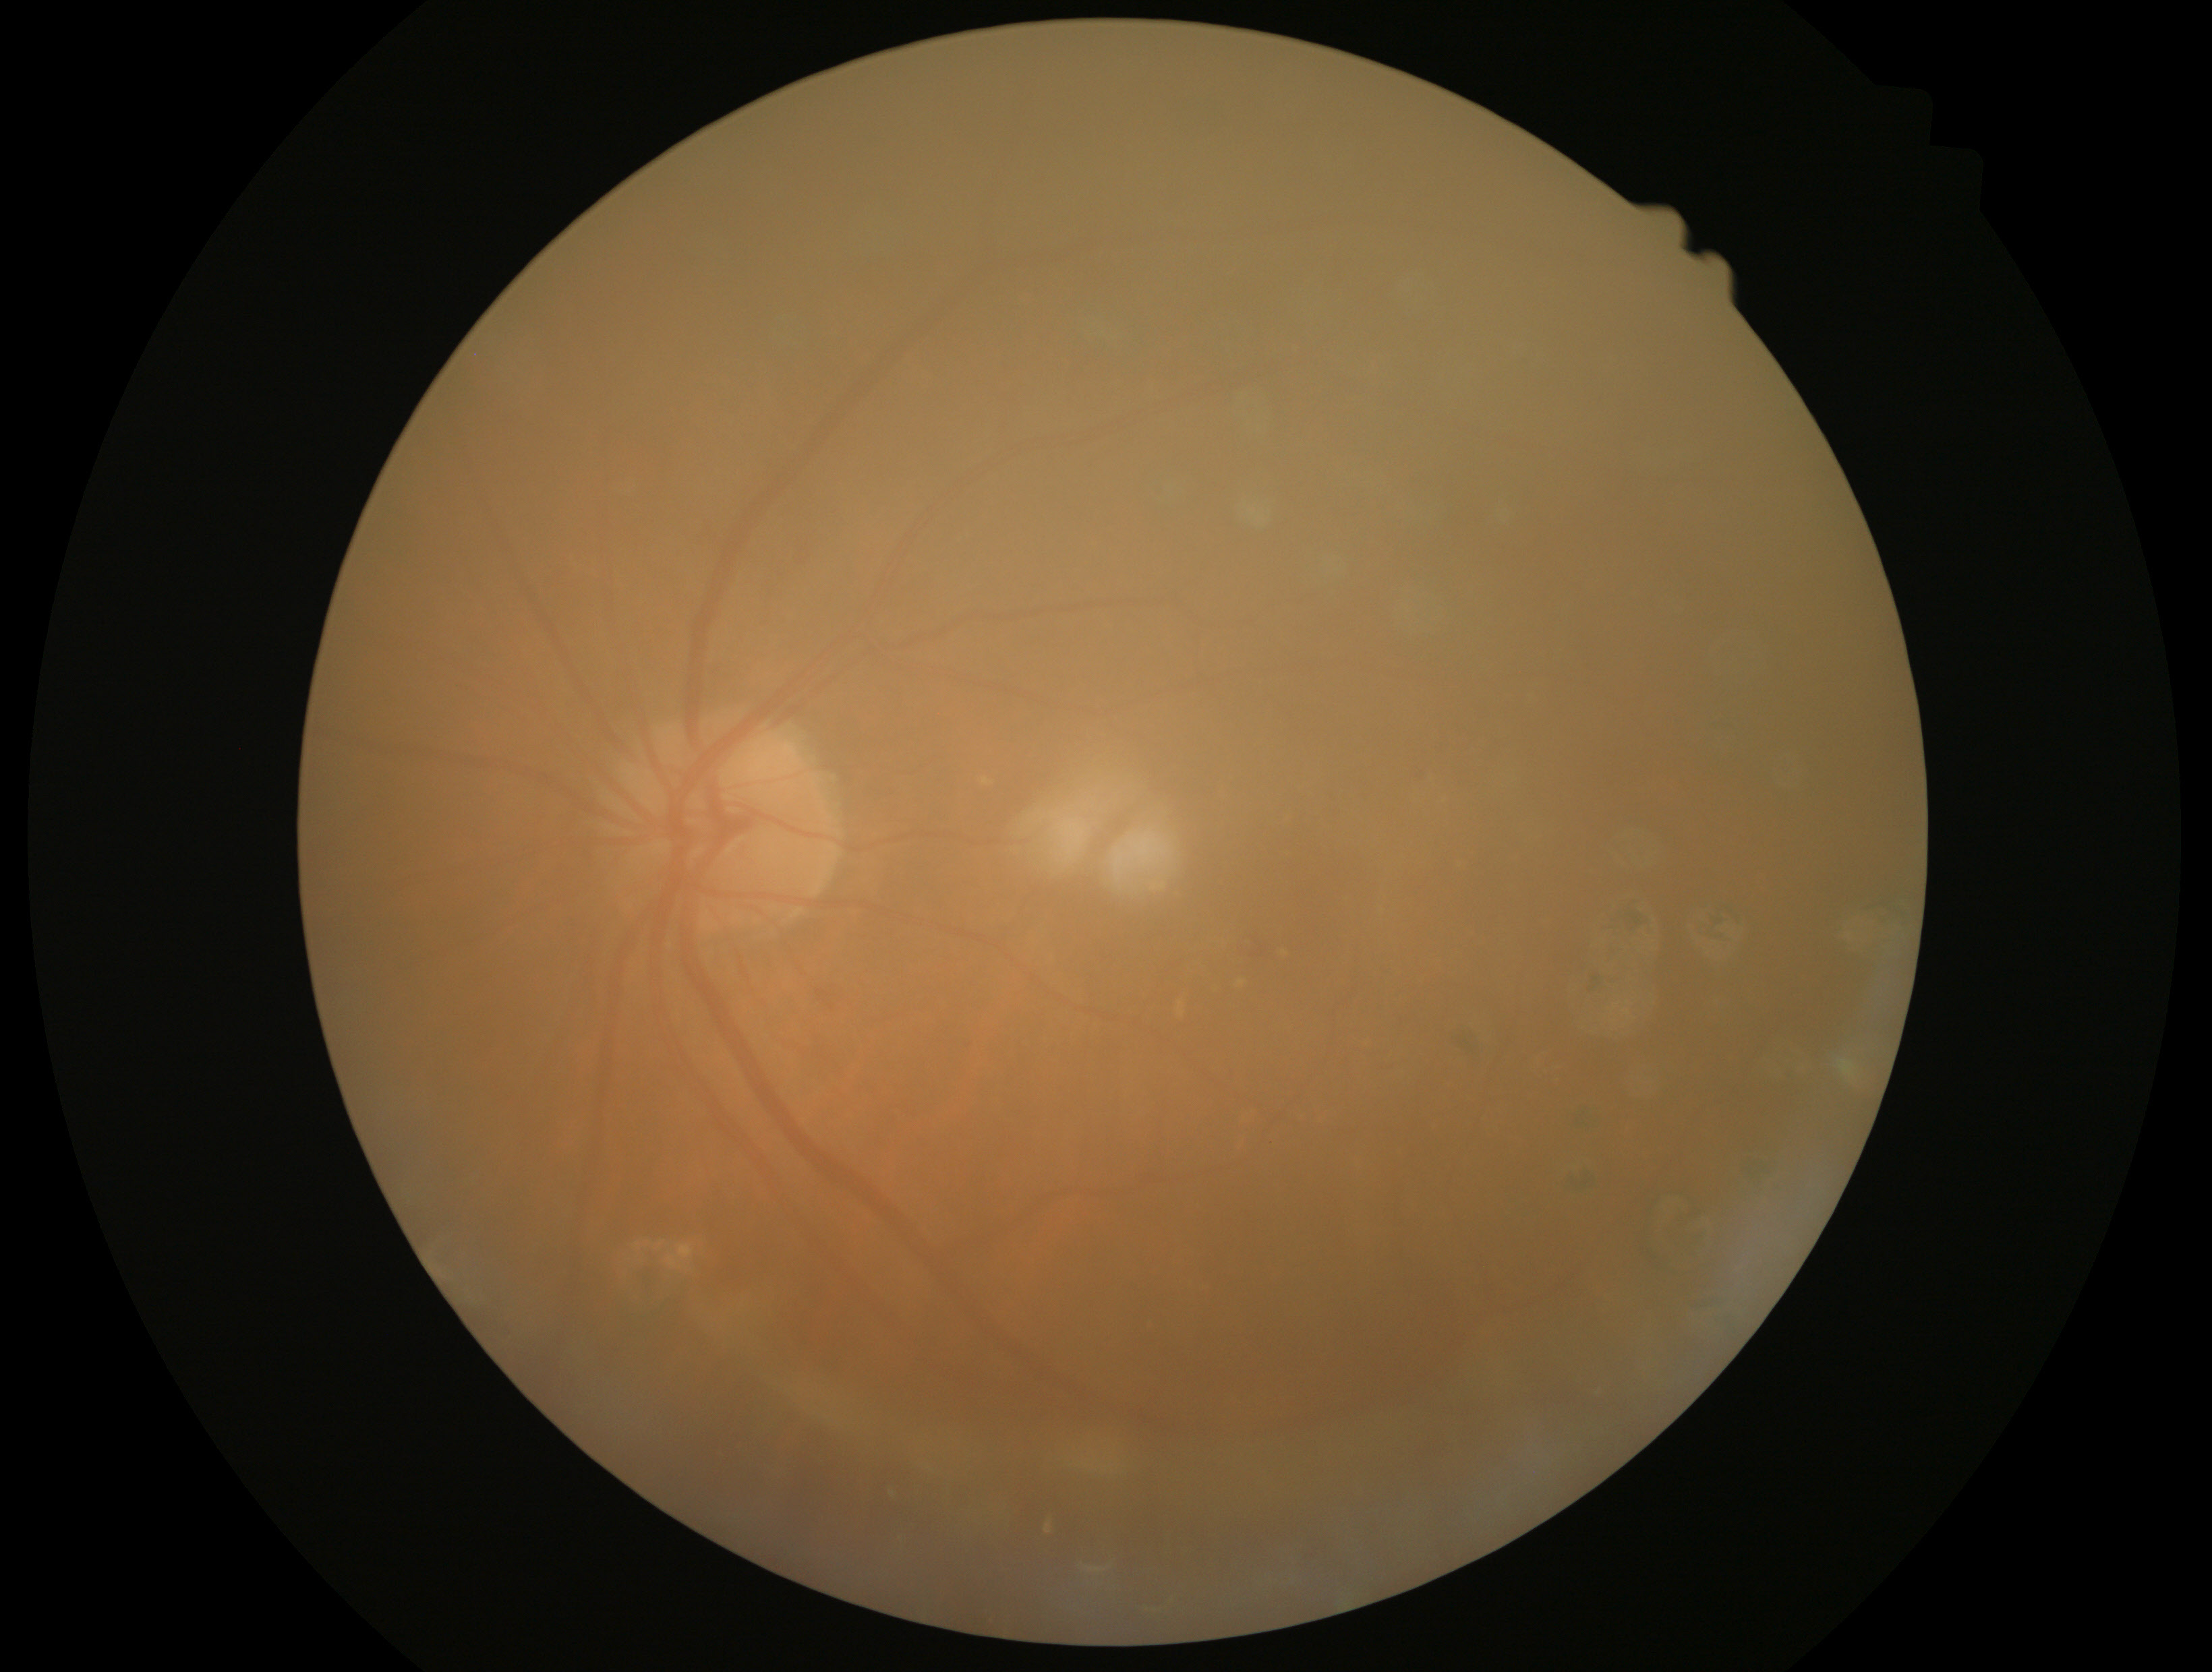
Diabetic retinopathy (DR): 2.